Without pupil dilation:
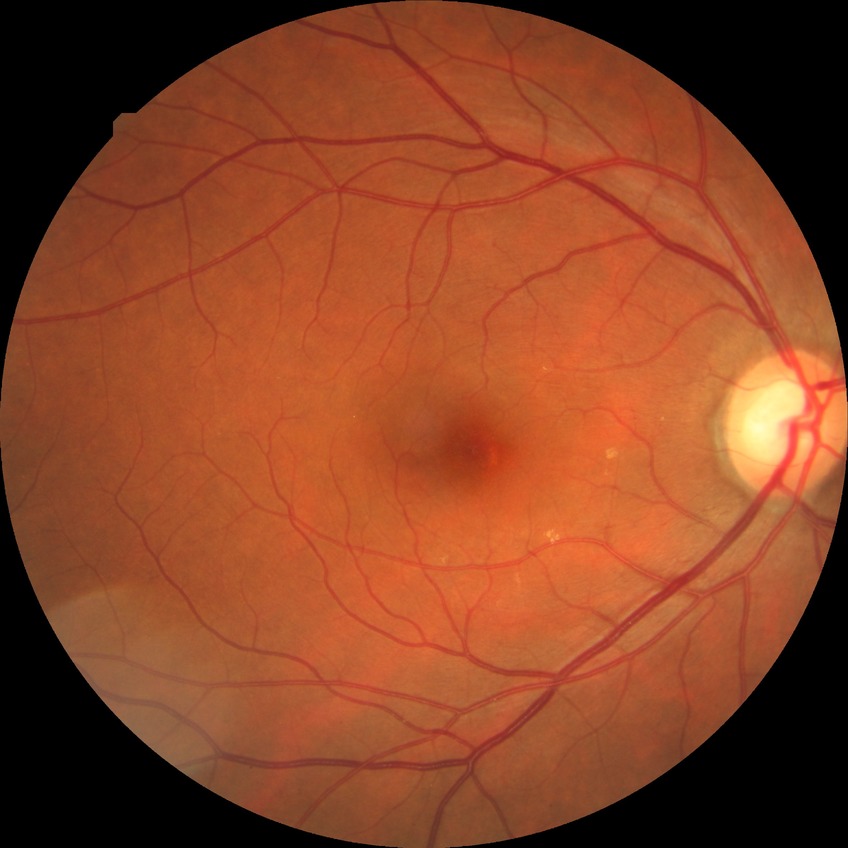

Modified Davis classification is no diabetic retinopathy.